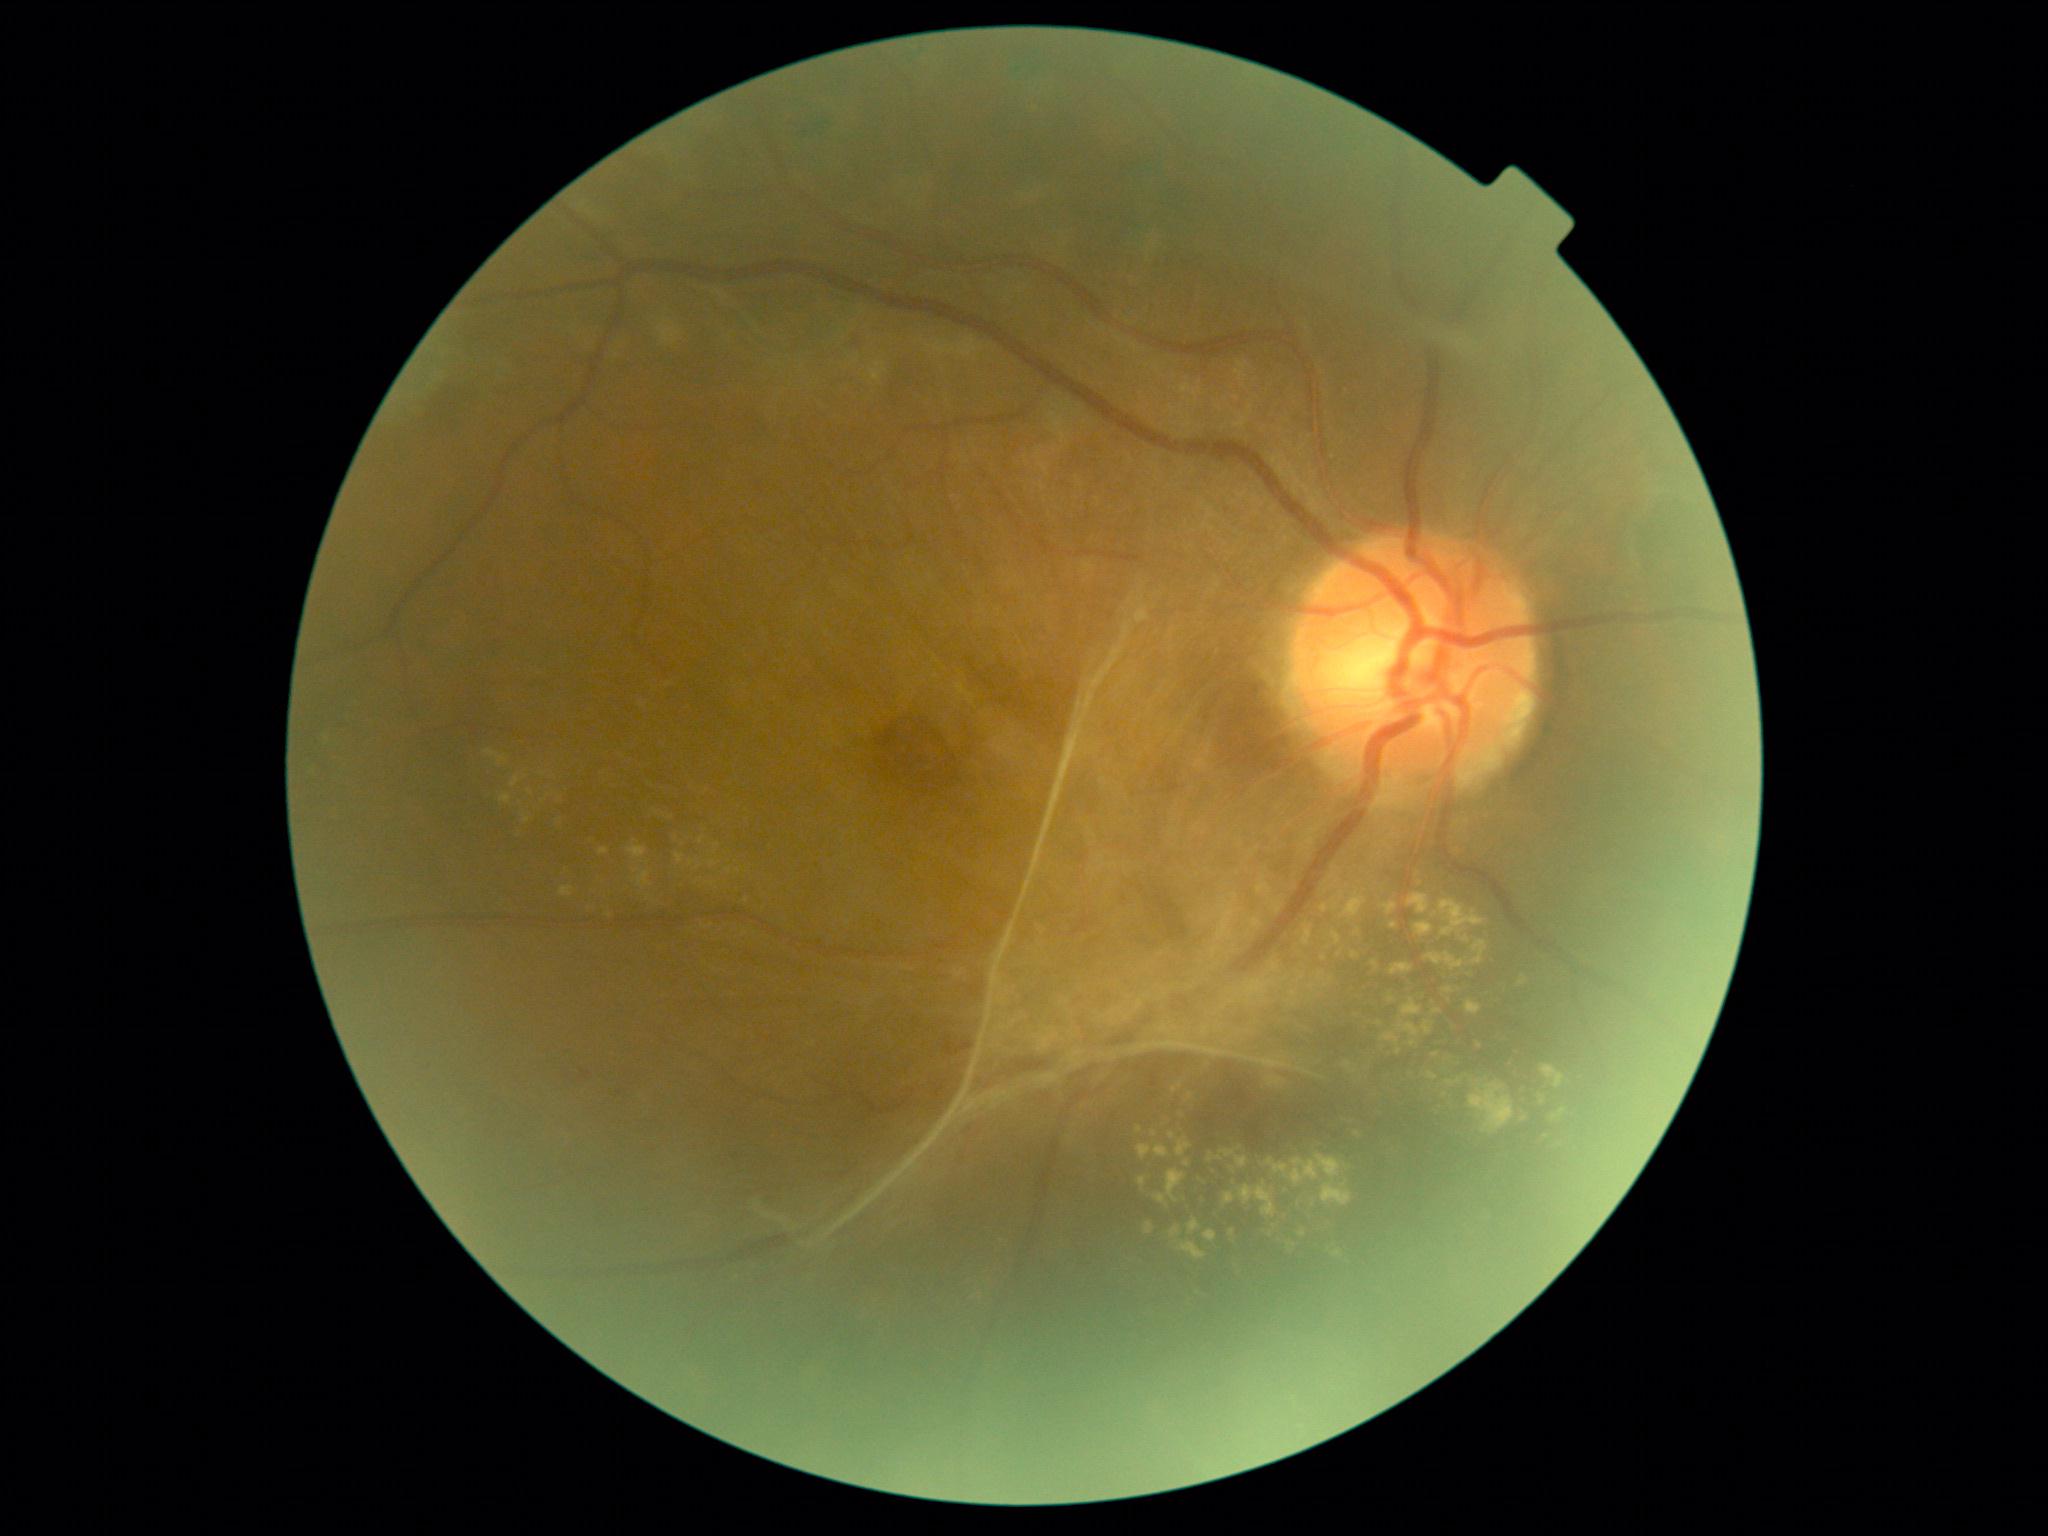

Diabetic retinopathy (DR) is 4.